Acquired with a Nidek AFC-330.
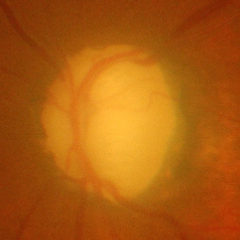 Fundus appearance consistent with severe glaucomatous damage.